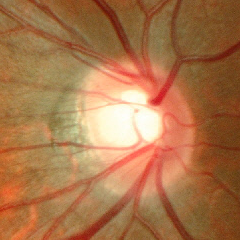 Q: Does this eye have glaucoma?
A: Early-stage glaucoma.